848 x 848 pixels · acquired with a NIDEK AFC-230 · 45° field of view · without pupil dilation:
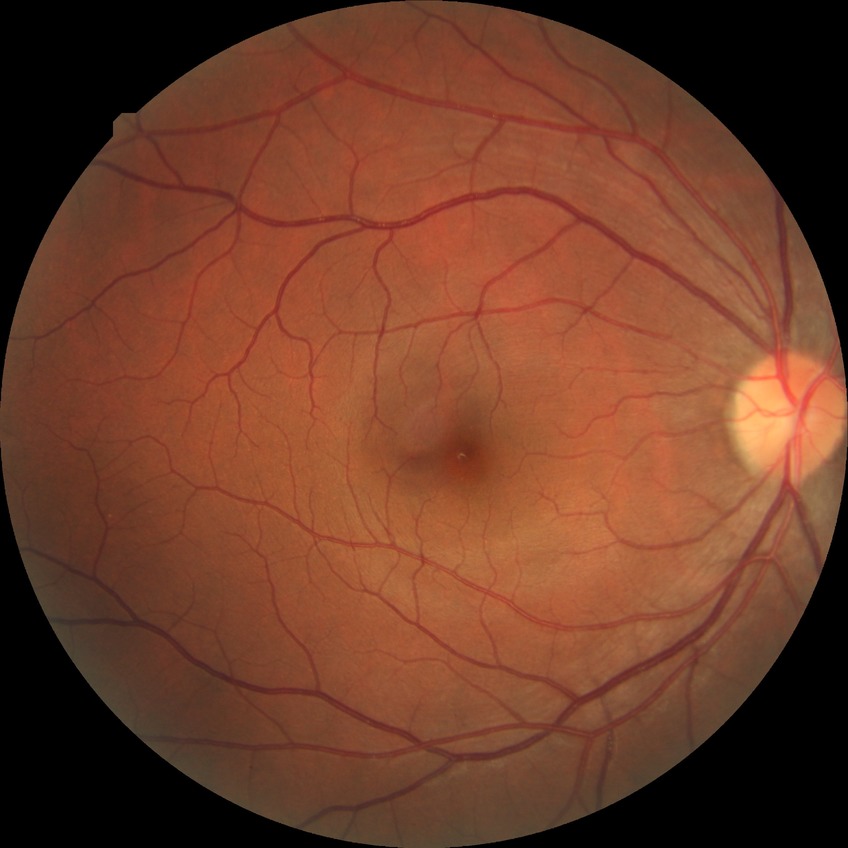 {"davis_grade": "simple diabetic retinopathy"}